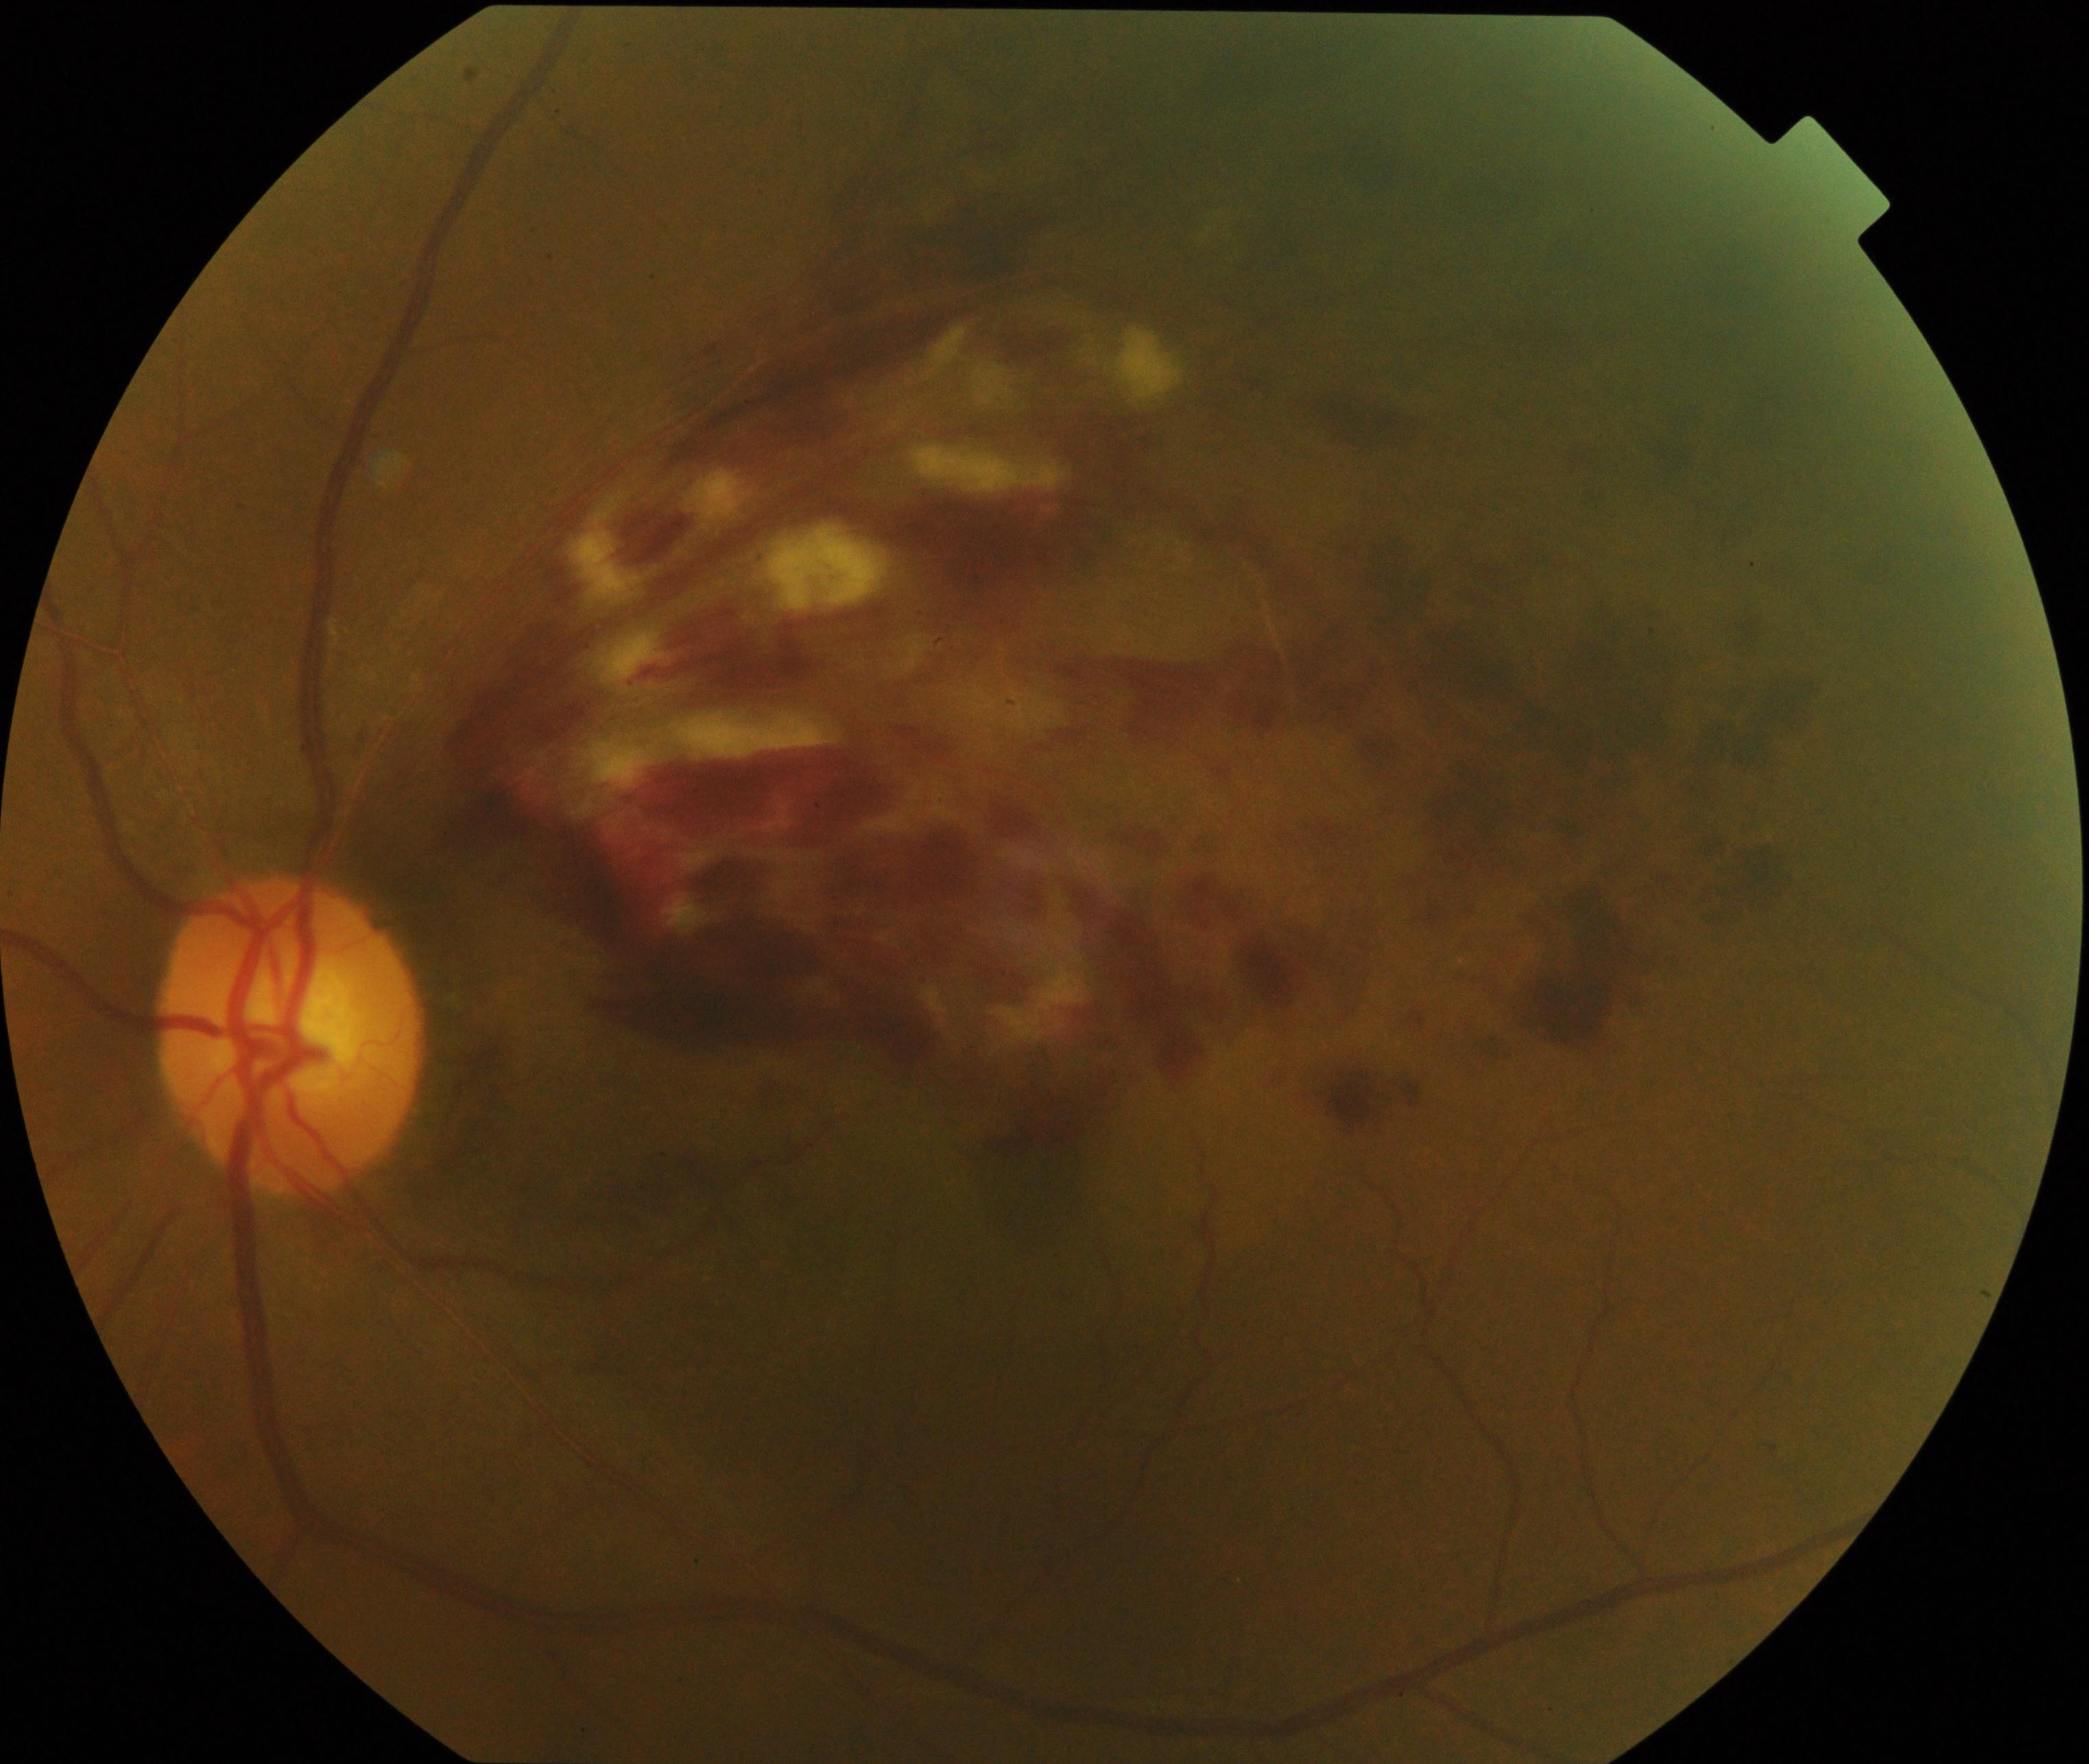
Primary finding: branch retinal vein occlusion.